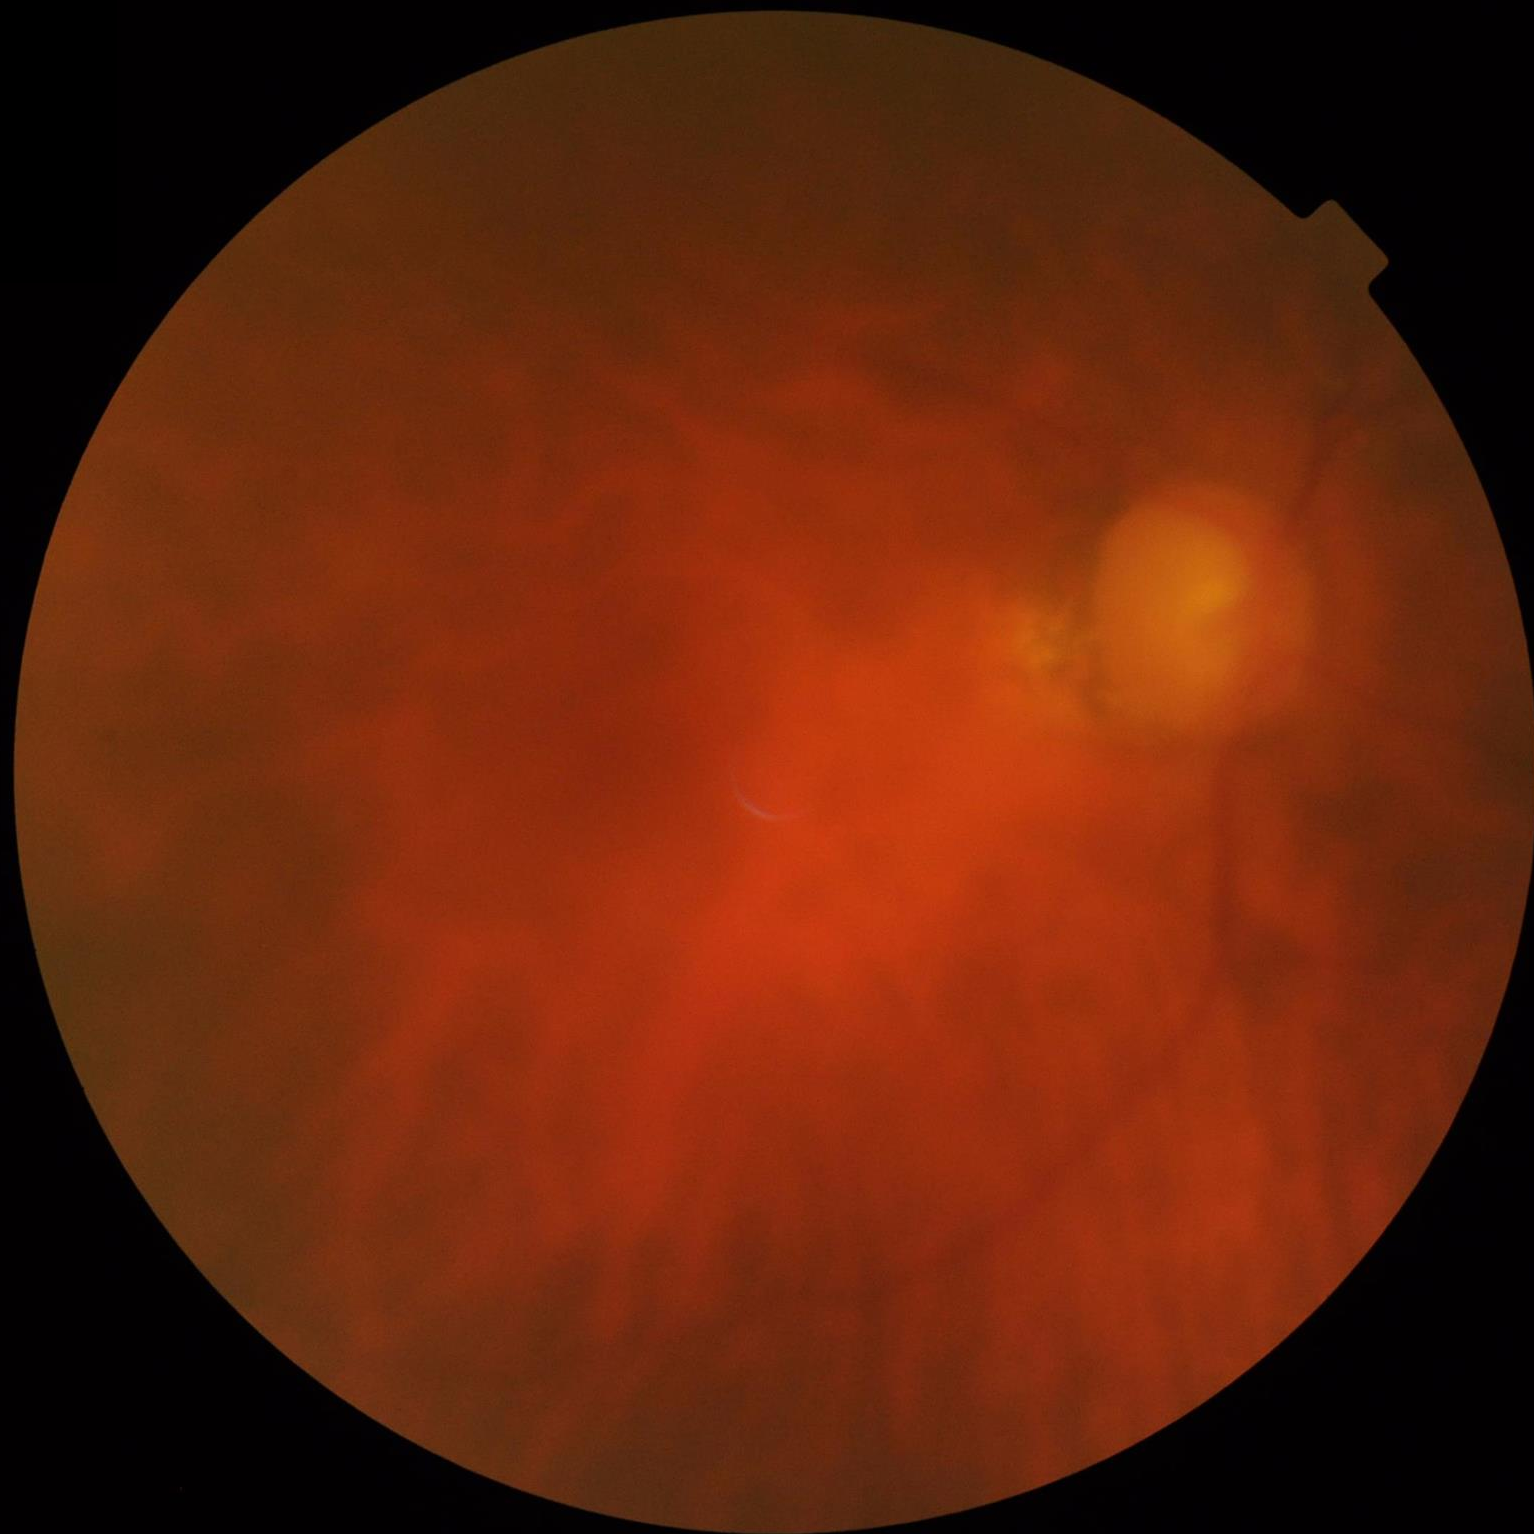
{
  "illumination": "poor",
  "overall_quality": "low",
  "contrast": "reduced",
  "clarity": "blurry"
}